Pediatric wide-field fundus photograph — 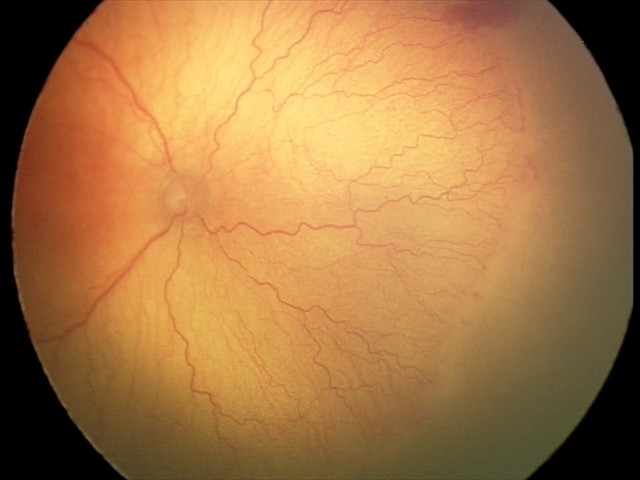
Plus disease was diagnosed. Screening series with aggressive retinopathy of prematurity (A-ROP).